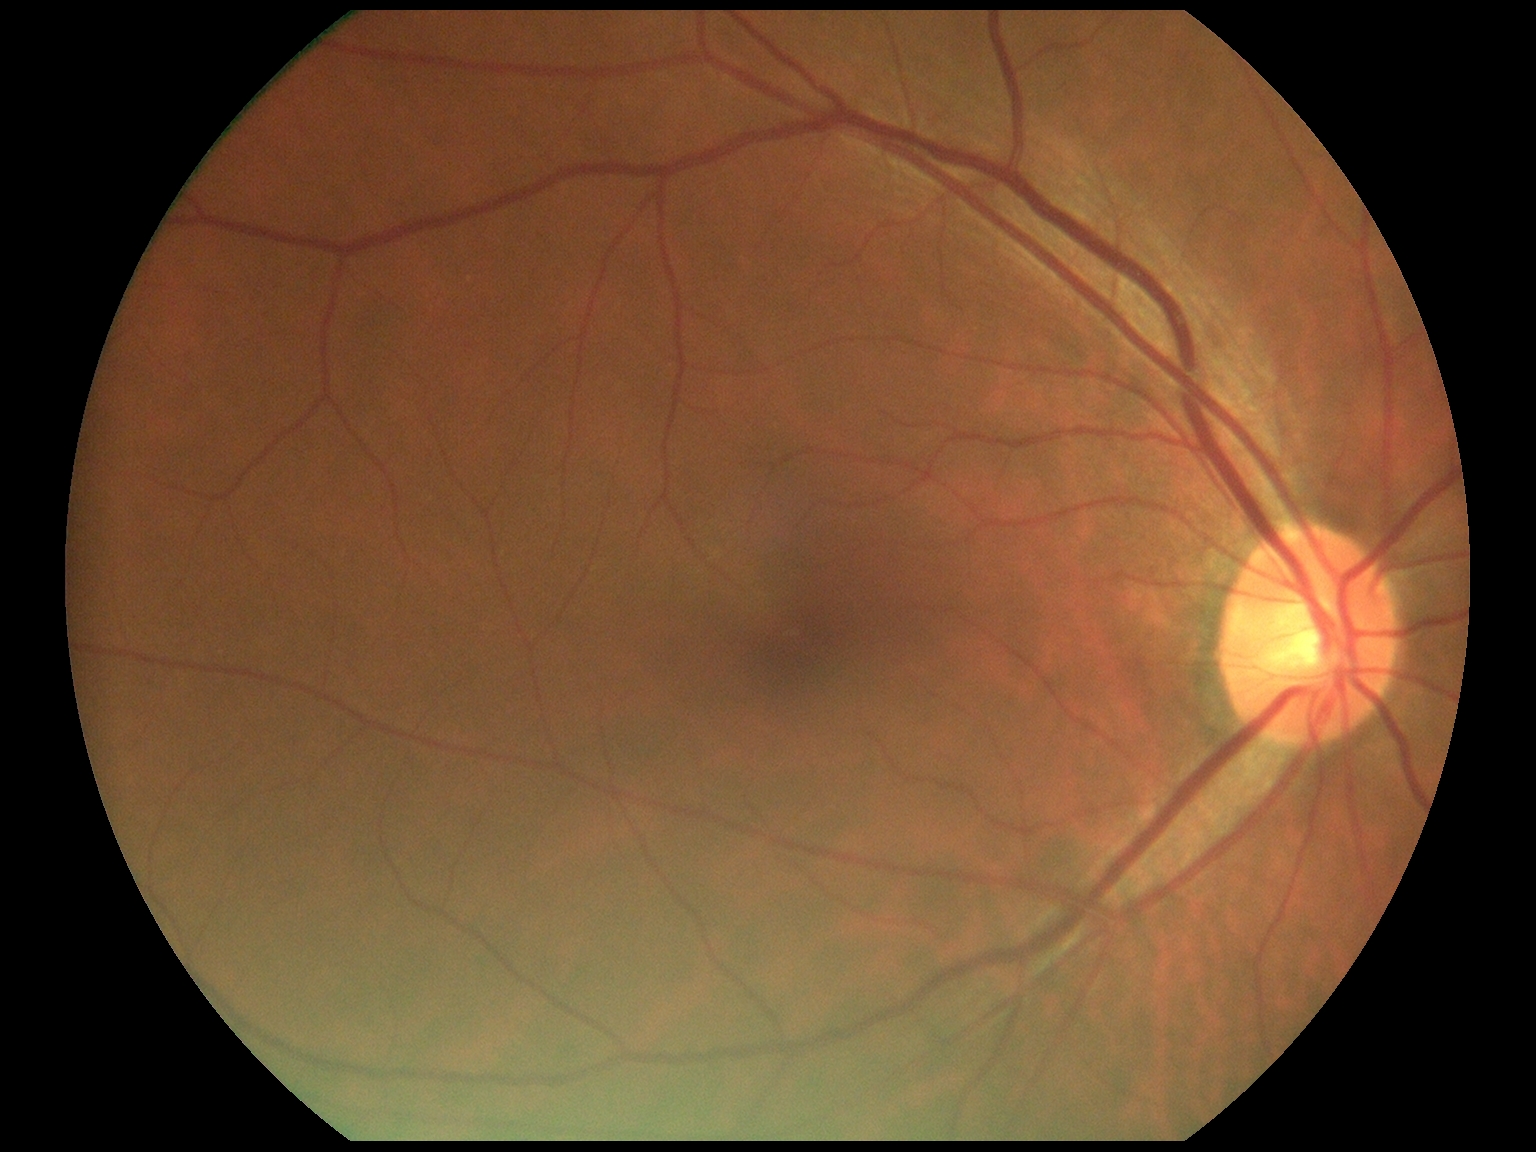

No DR findings.
Diabetic retinopathy is no apparent diabetic retinopathy (grade 0).